Non-mydriatic; cropped to the optic nerve head; image size 240x240:
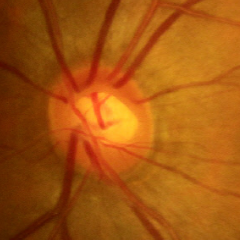

This fundus photograph shows early glaucoma.